45-degree field of view.
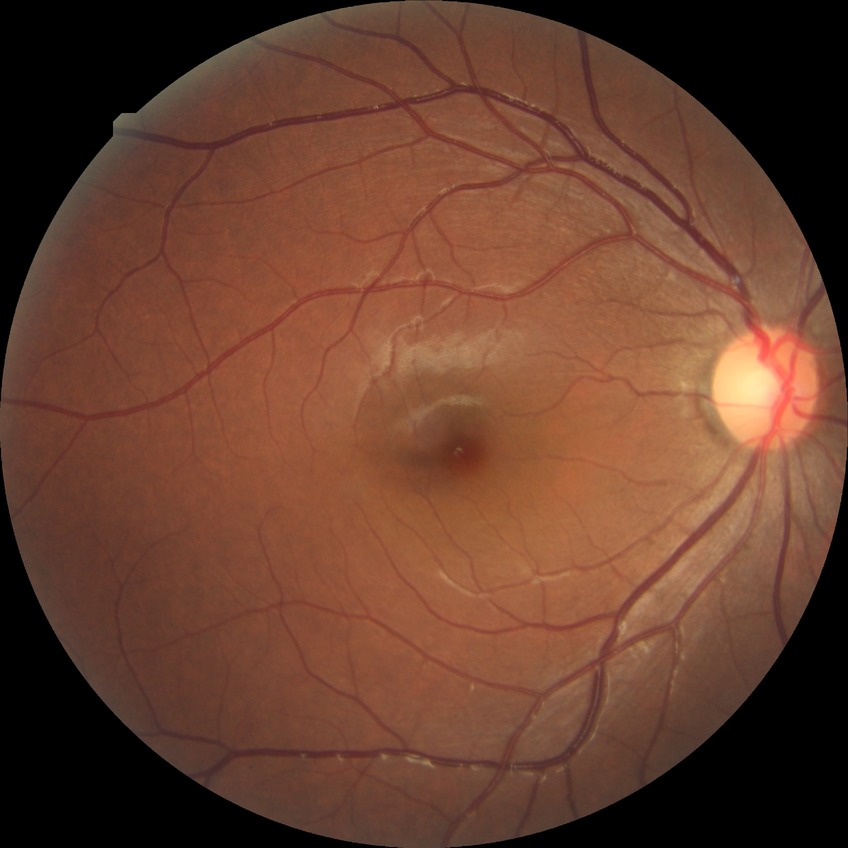
Diabetic retinopathy (DR) is no diabetic retinopathy (NDR).